Modified Davis grading:
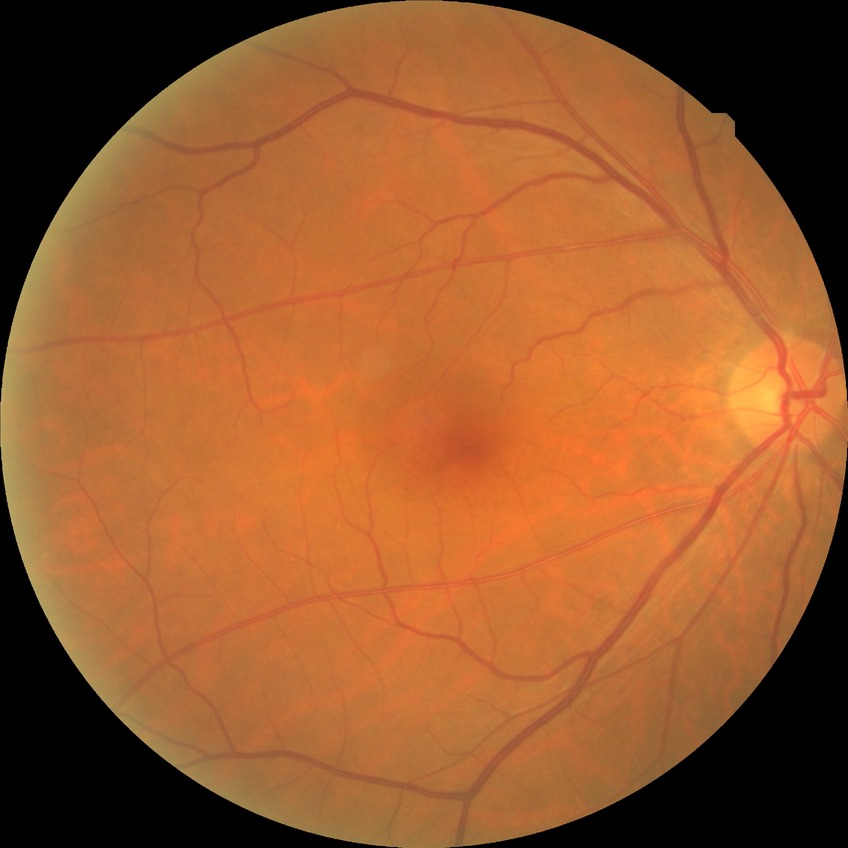 {"dr_impression": "no signs of DR", "davis_grade": "NDR"}